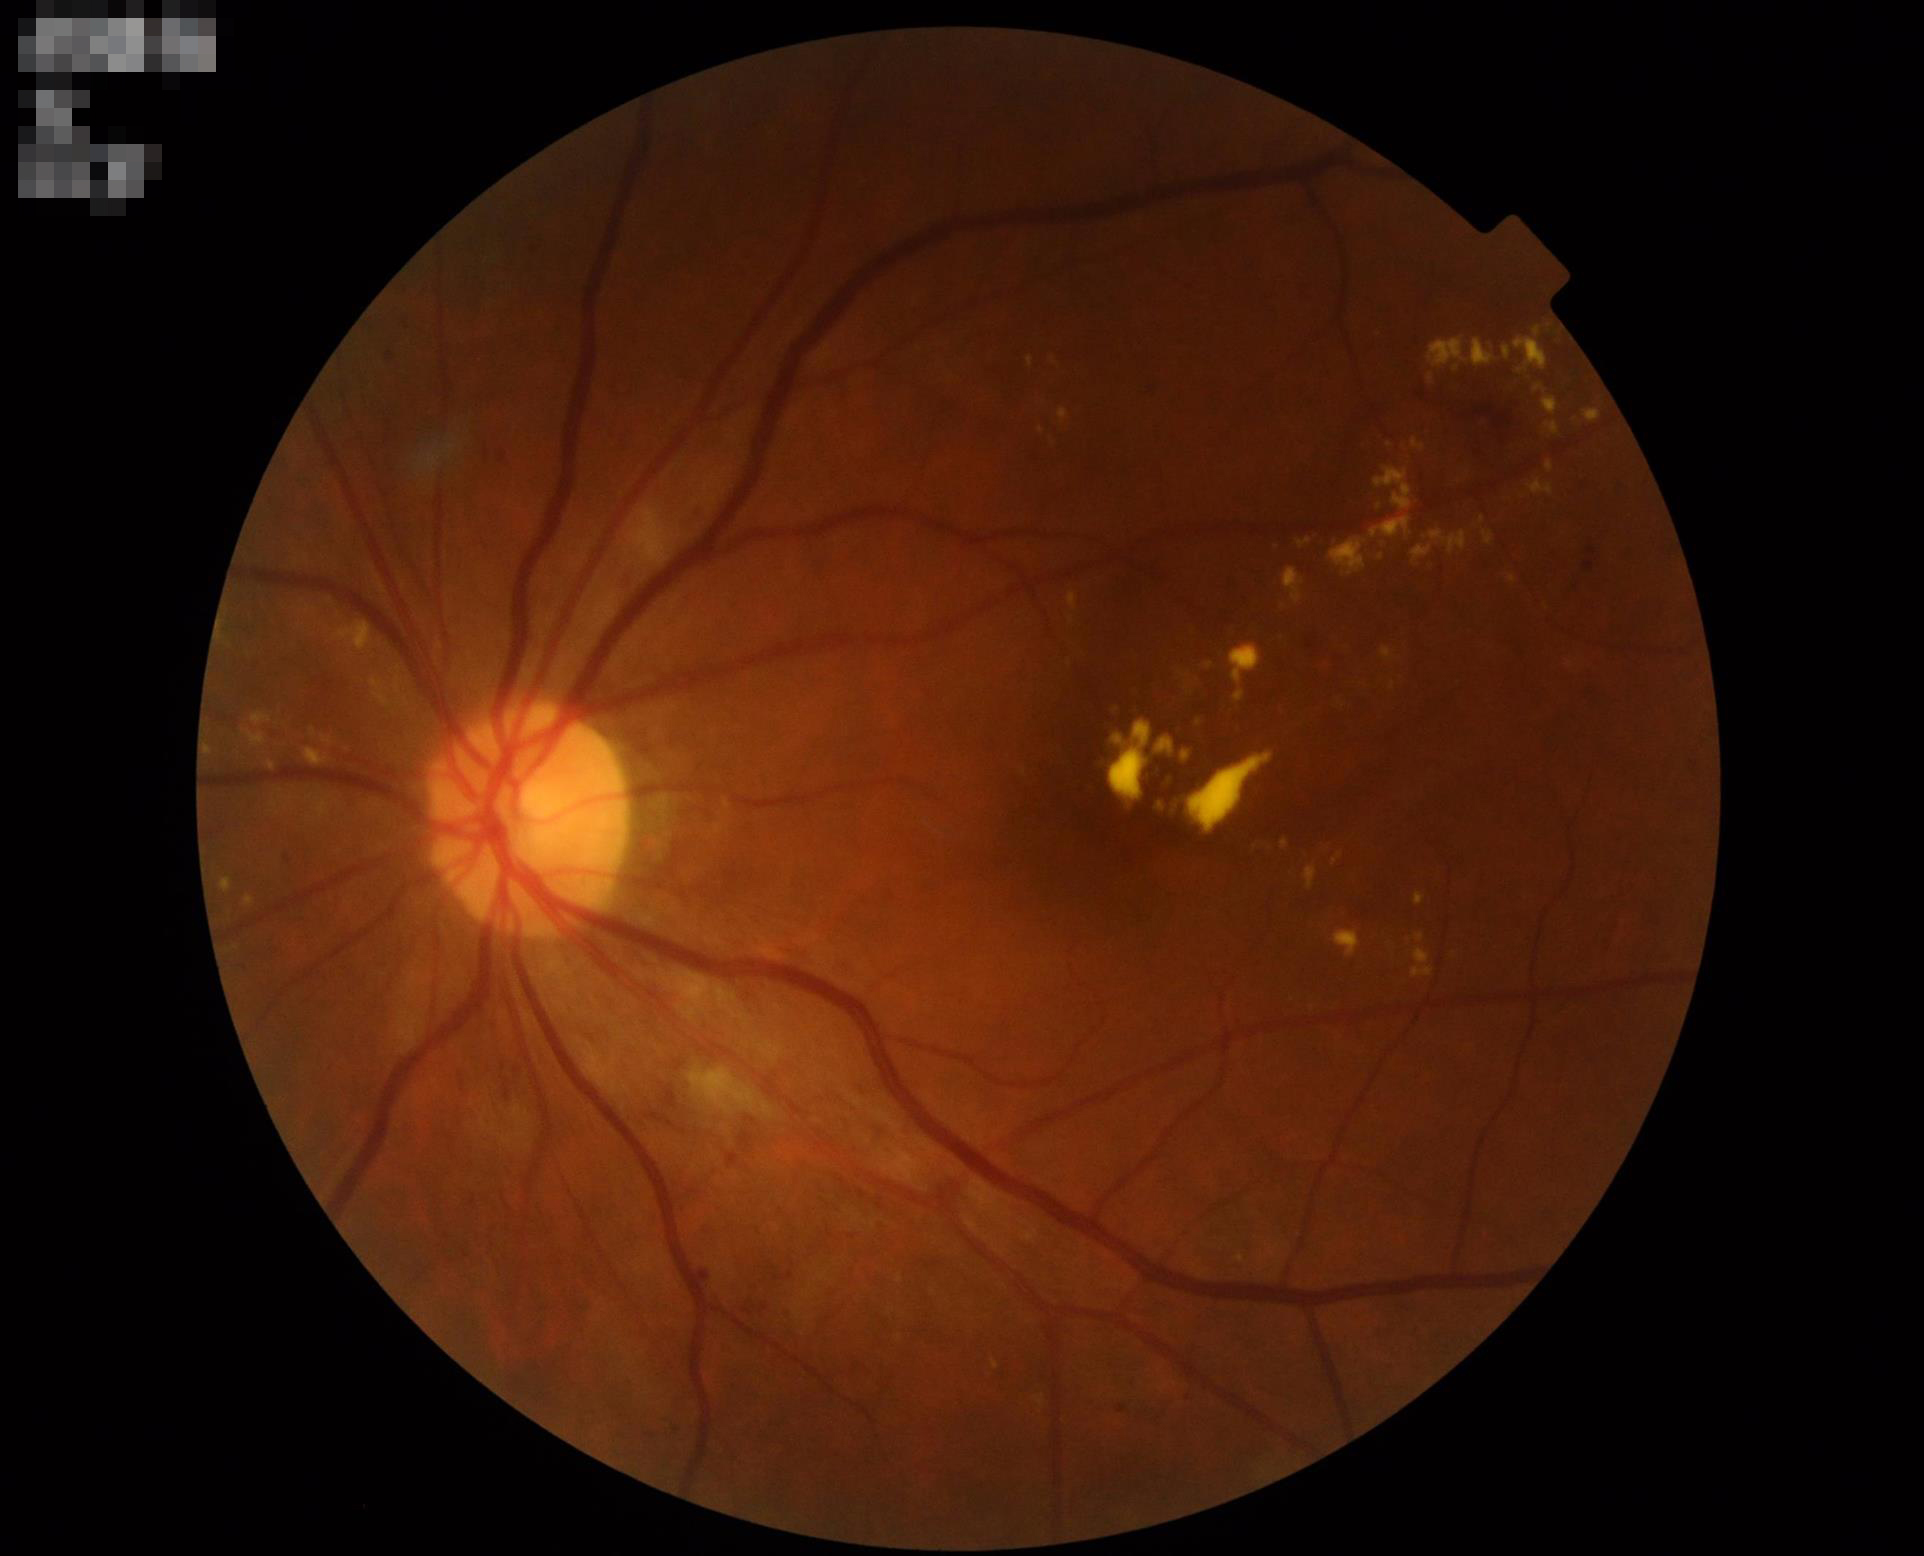

Image quality assessment: contrast: adequate | focus: sharp | overall: acceptable.